2352 x 1568 pixels:
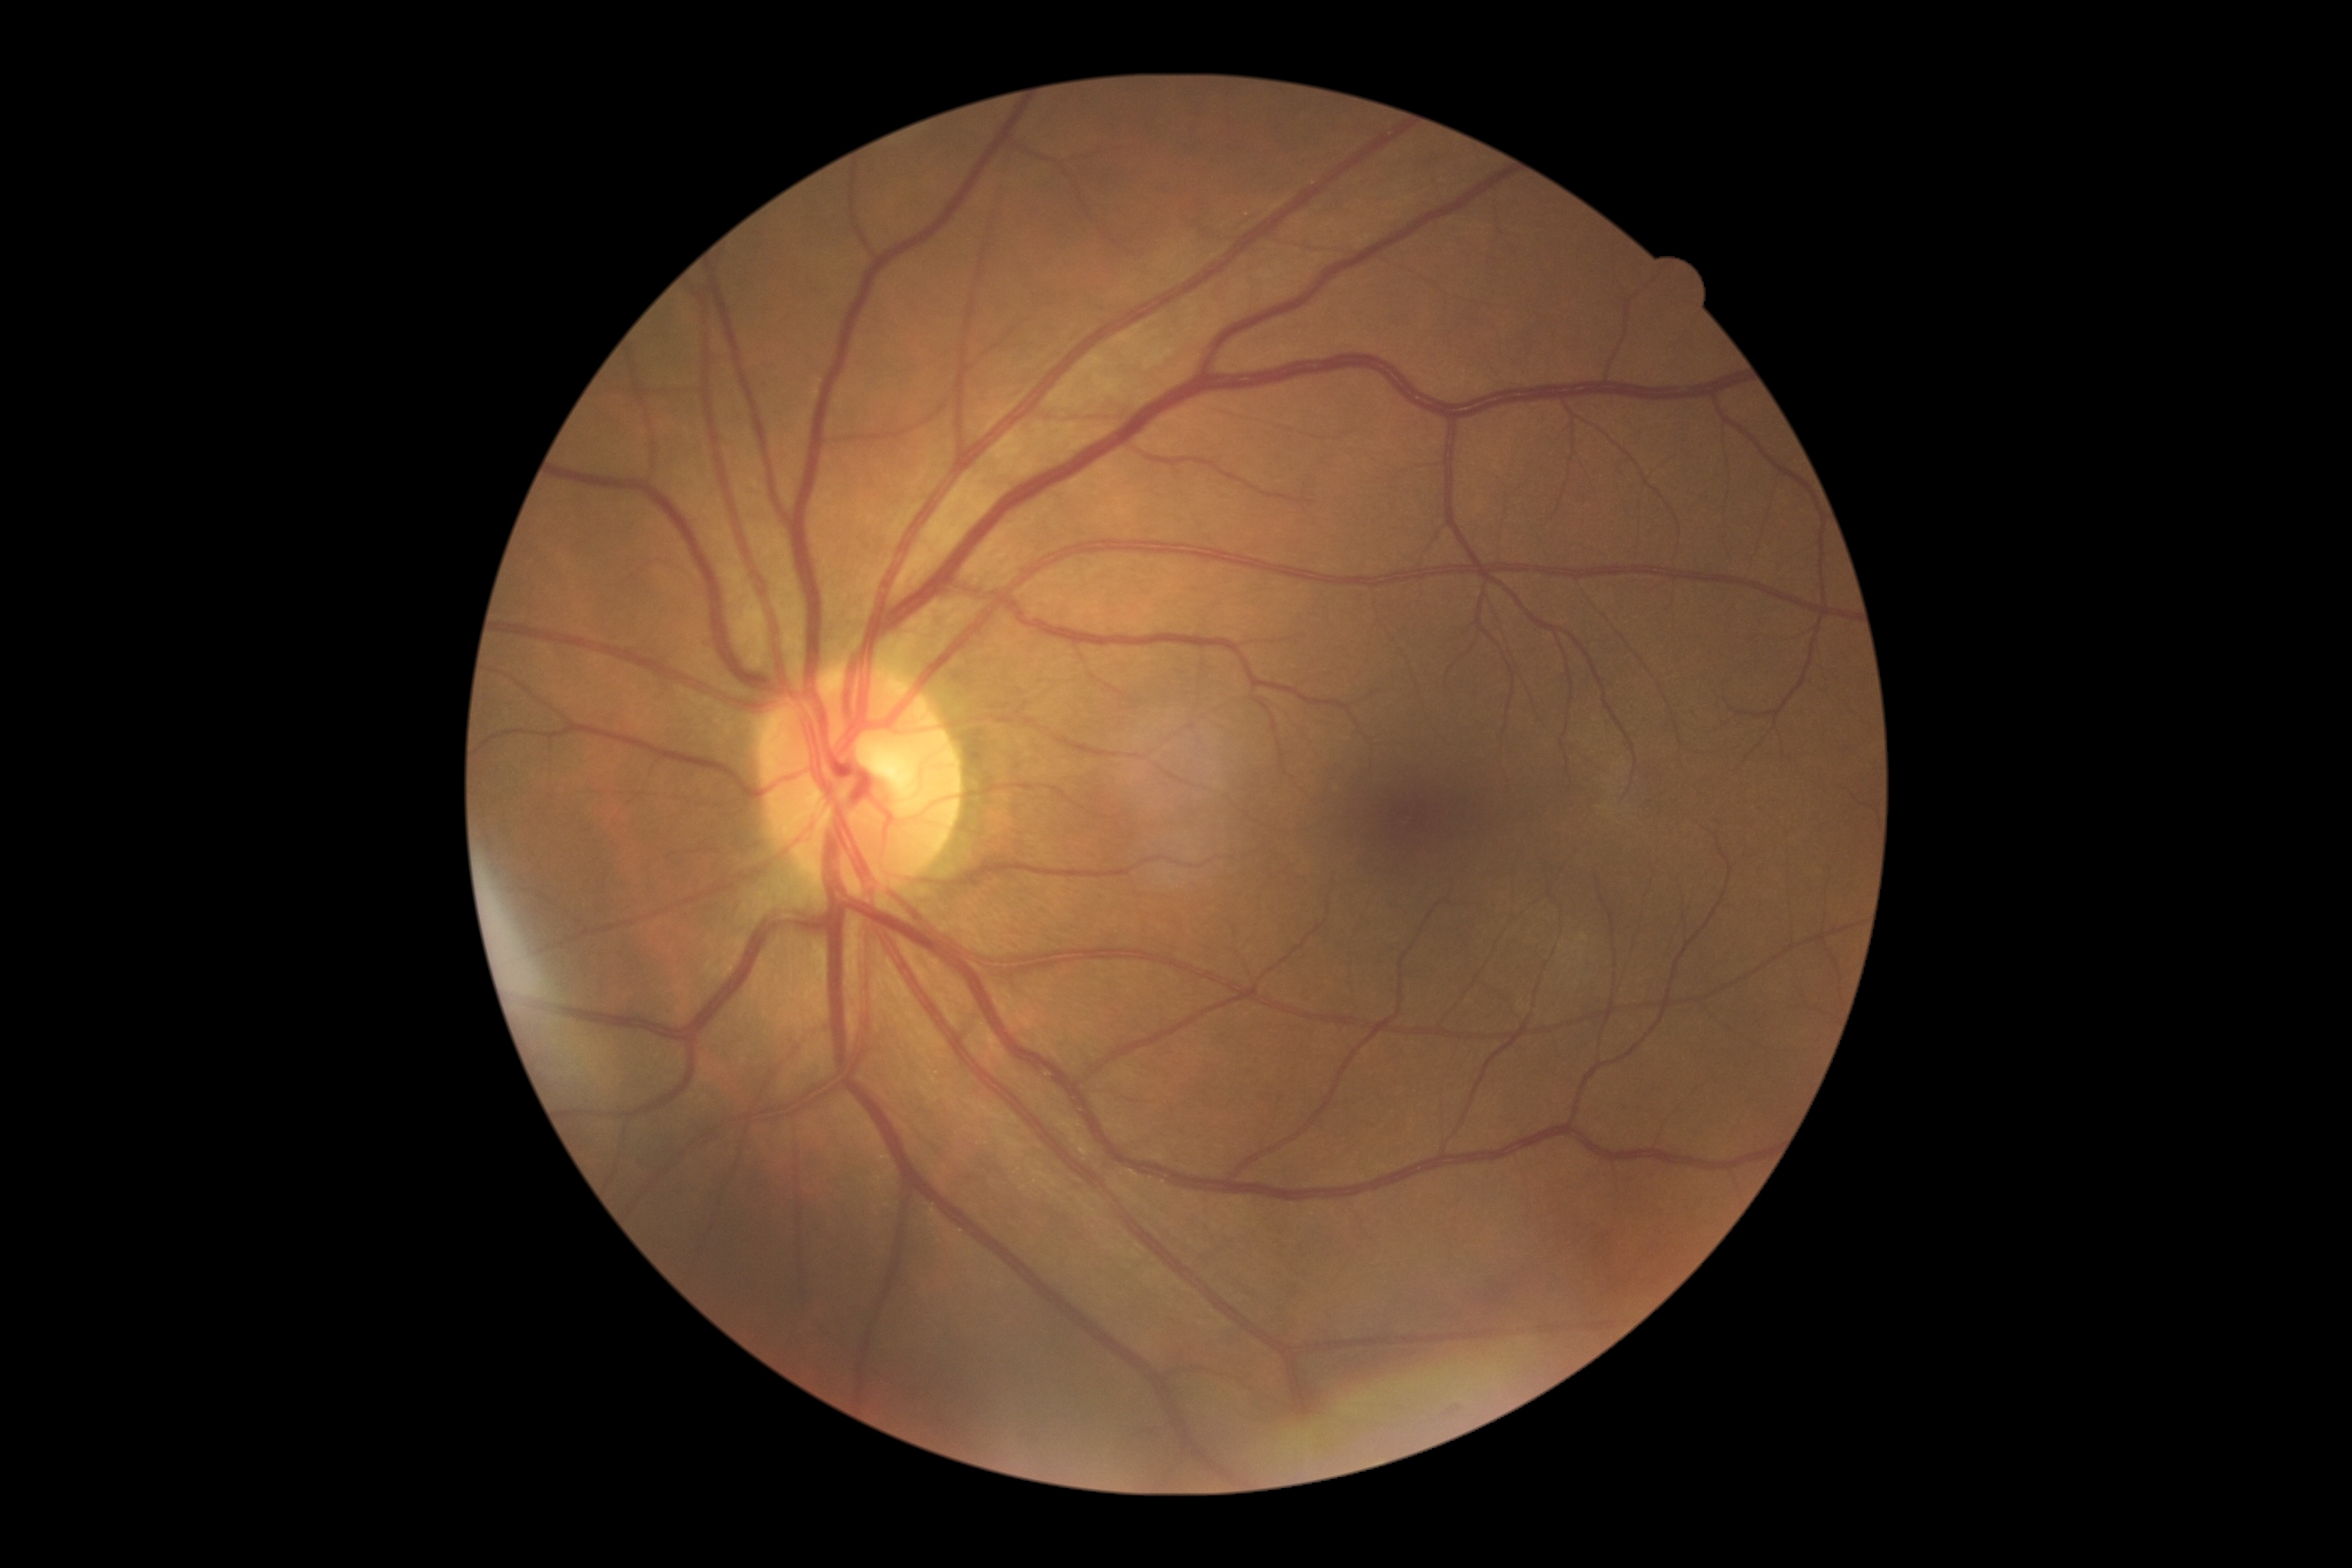

DR severity is 0.